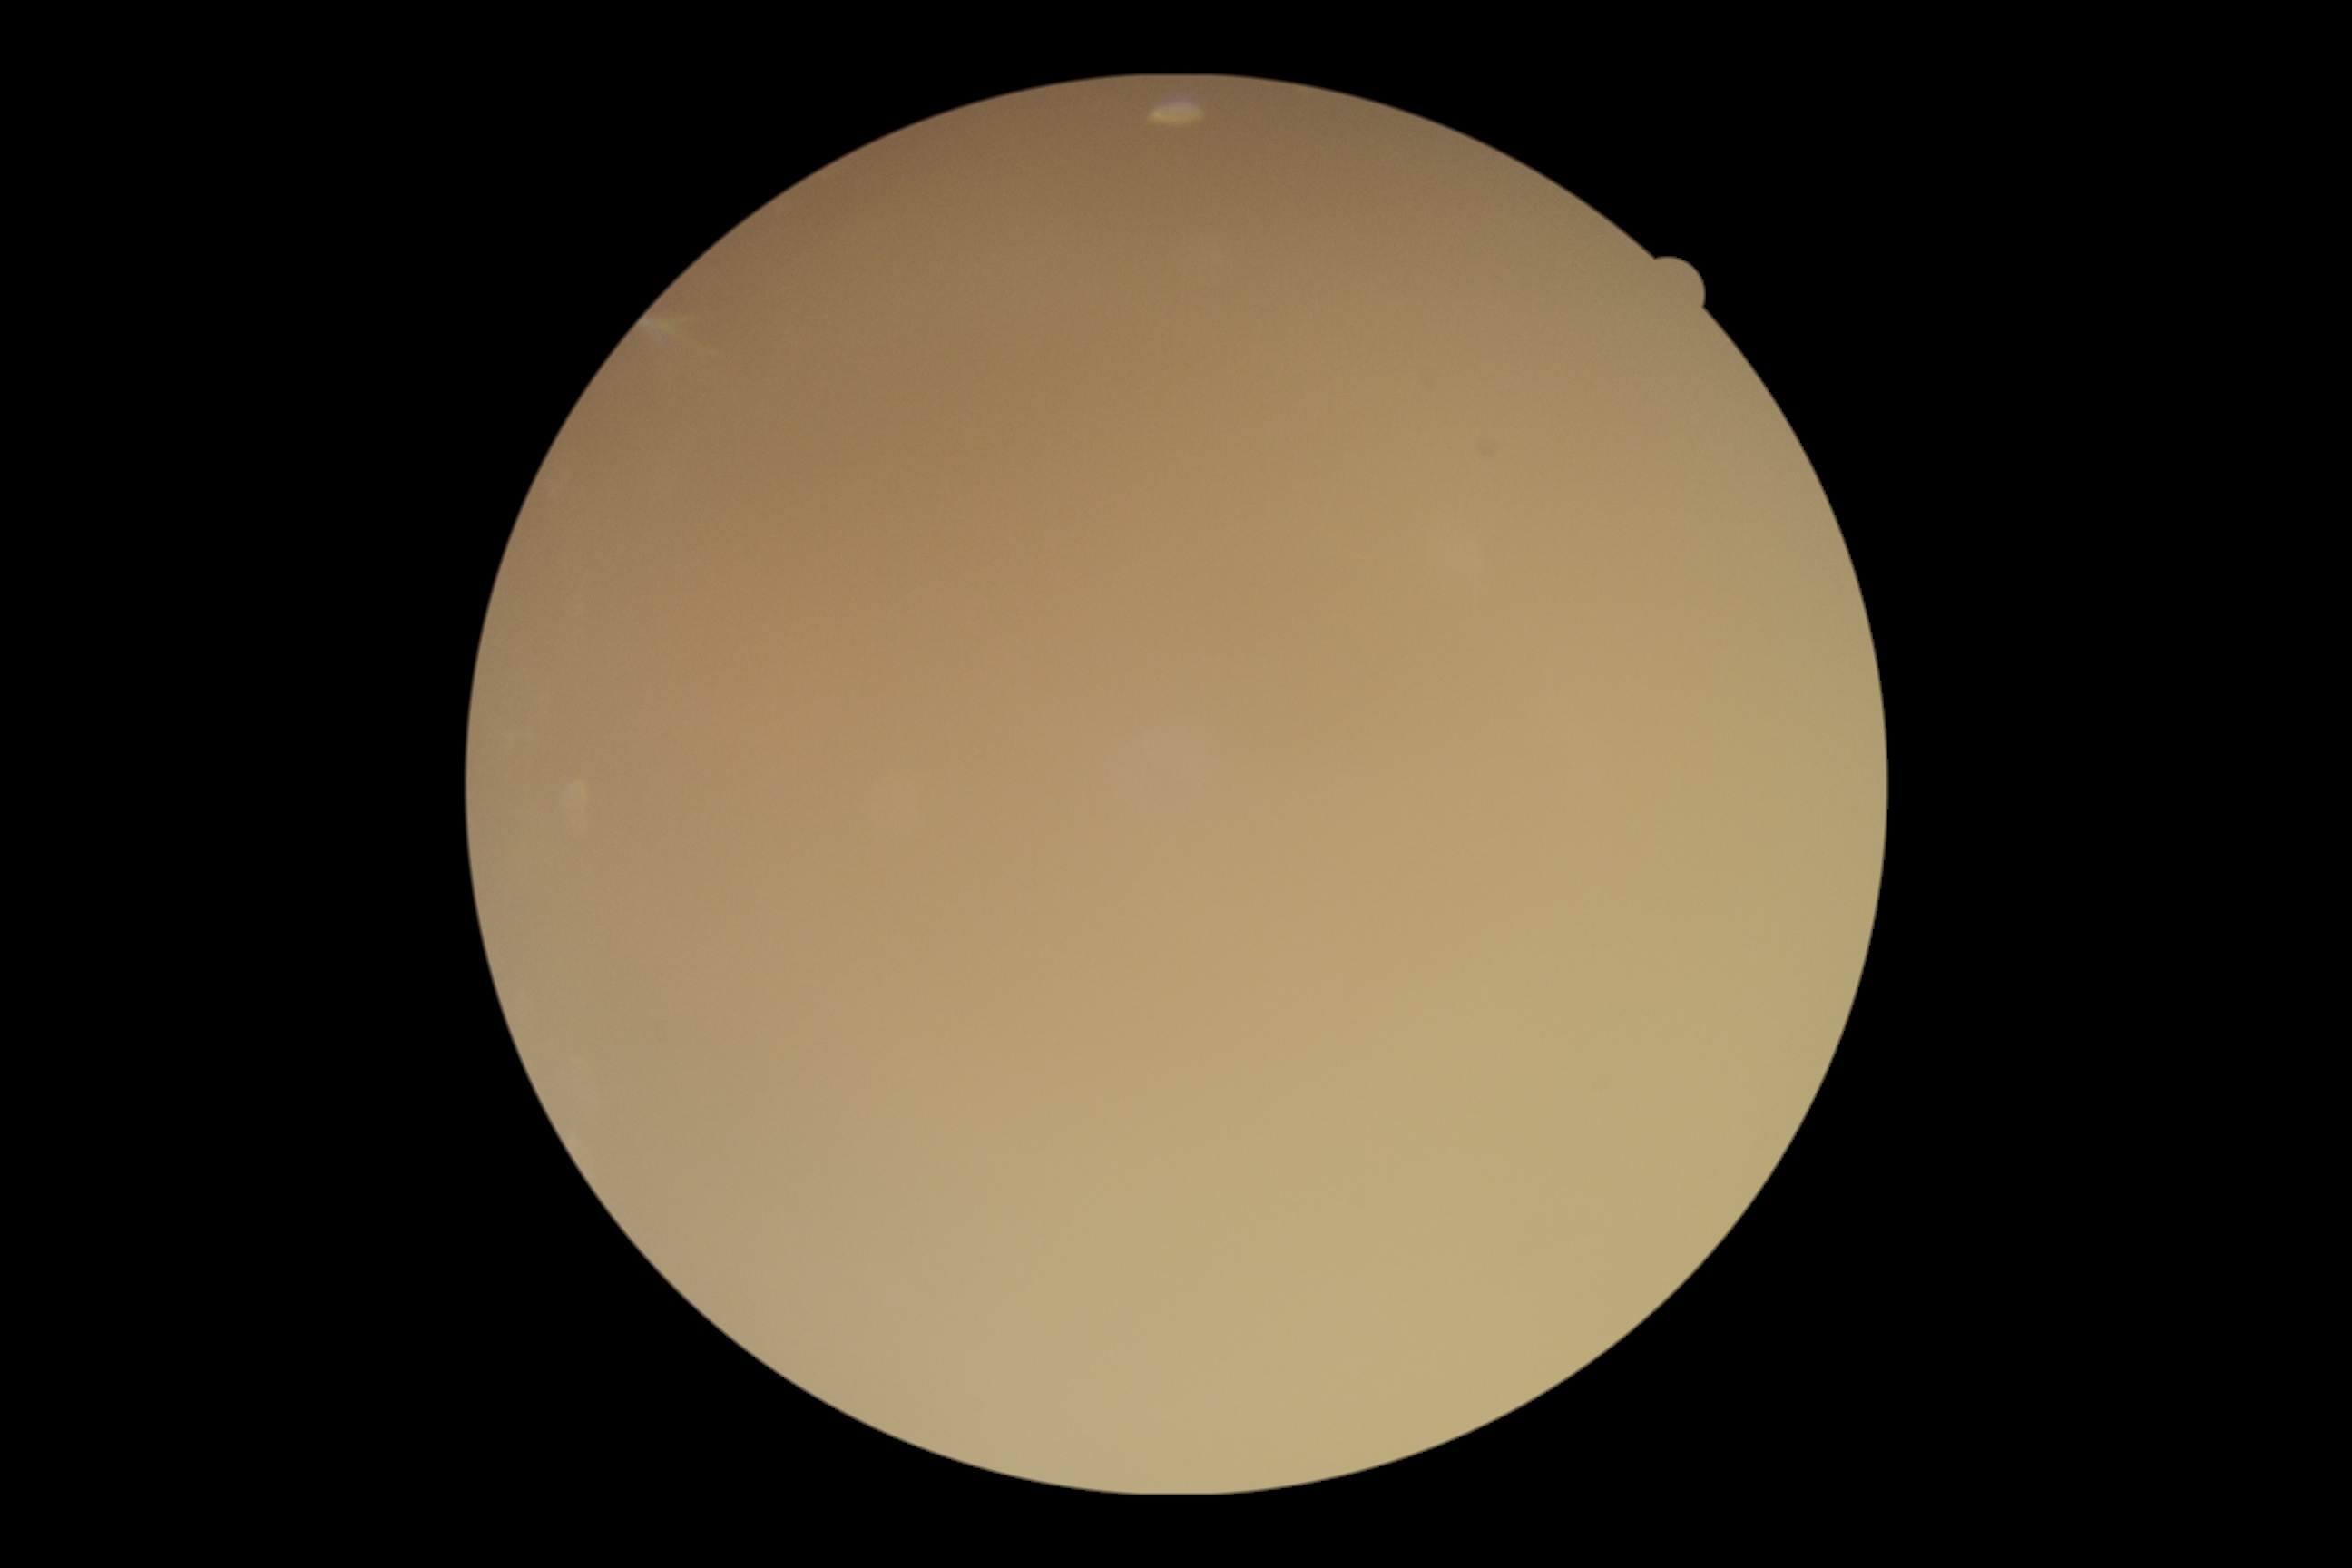

Diabetic retinopathy severity: ungradable.